Diabetic retinopathy graded by the modified Davis classification: 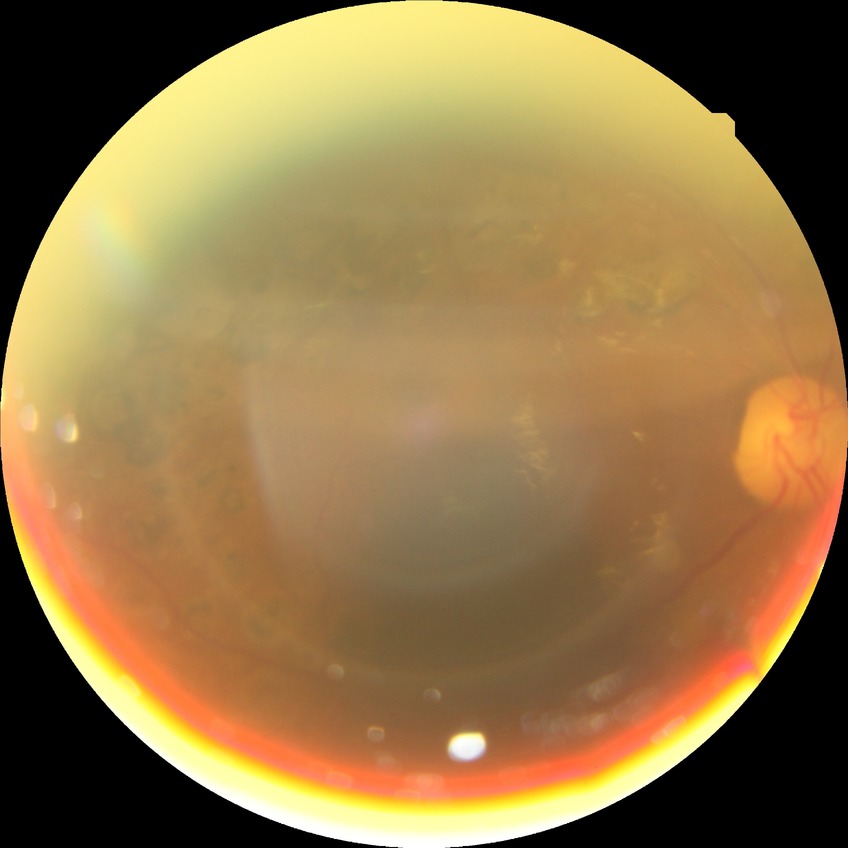 Retinopathy stage: proliferative diabetic retinopathy.